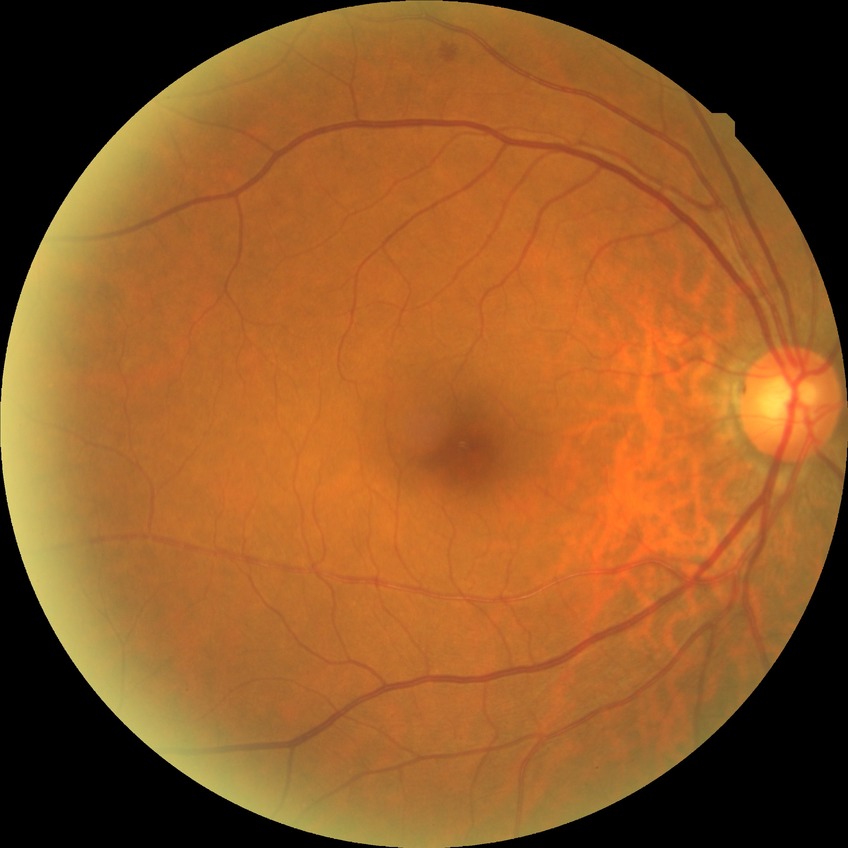 DR impression = negative for DR; Davis DR grade = NDR.